Color fundus photograph
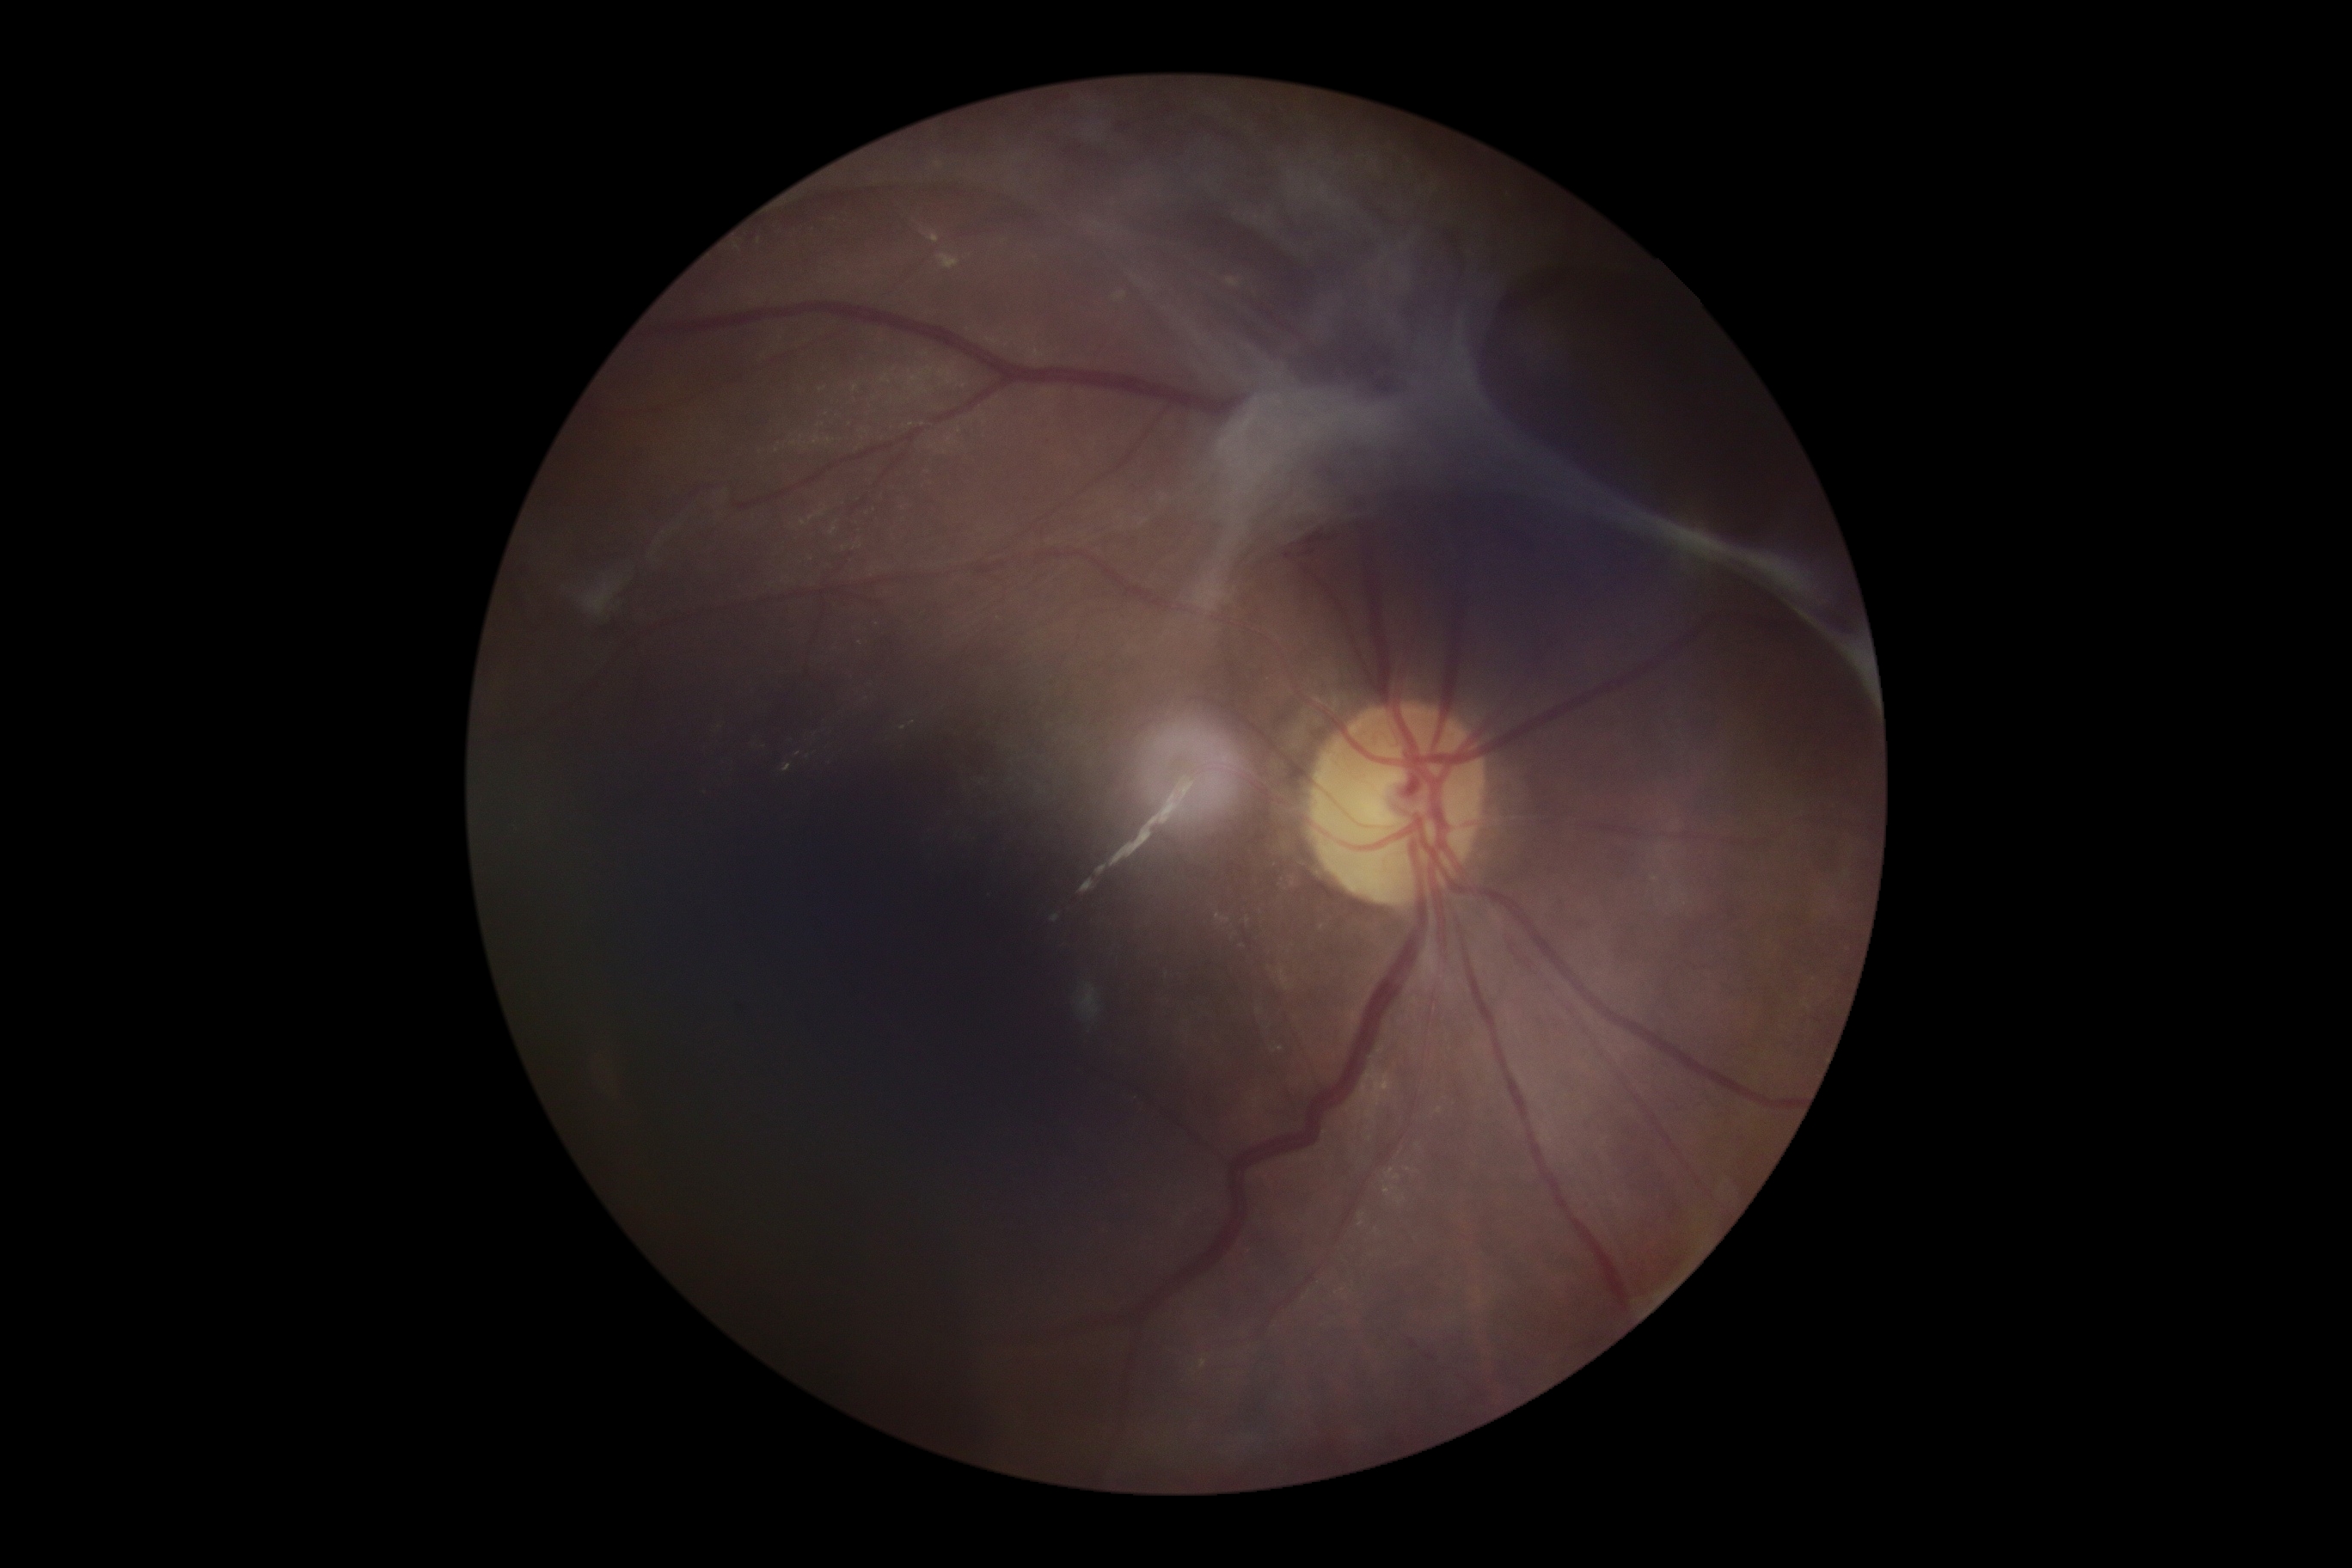
DR stage: grade 4.